Clarity RetCam 3, 130° FOV. Wide-field fundus photograph from neonatal ROP screening. 640x480px.
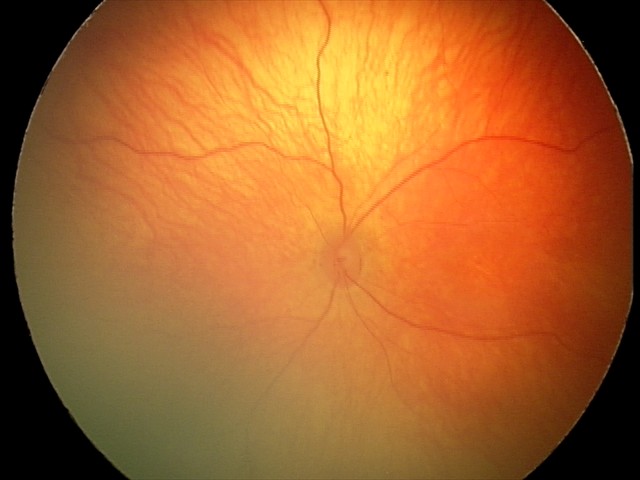 Assessment: no abnormal retinal findings.